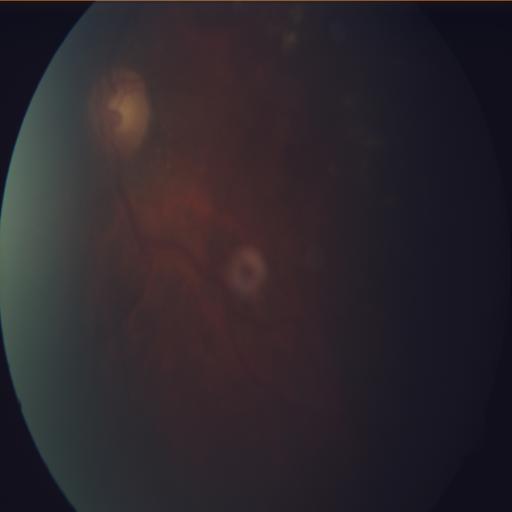 Impression:
- media haze (MH)